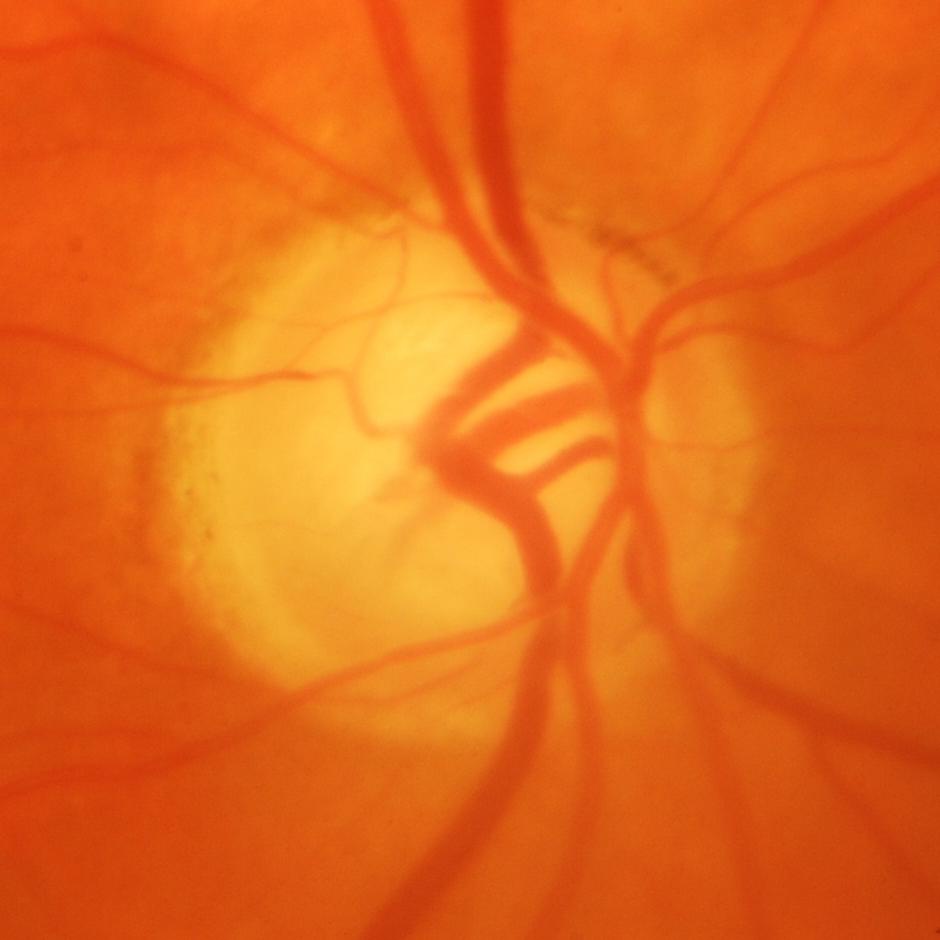
Glaucomatous optic neuropathy is present. Optic nerve head appearance consistent with glaucomatous optic neuropathy.